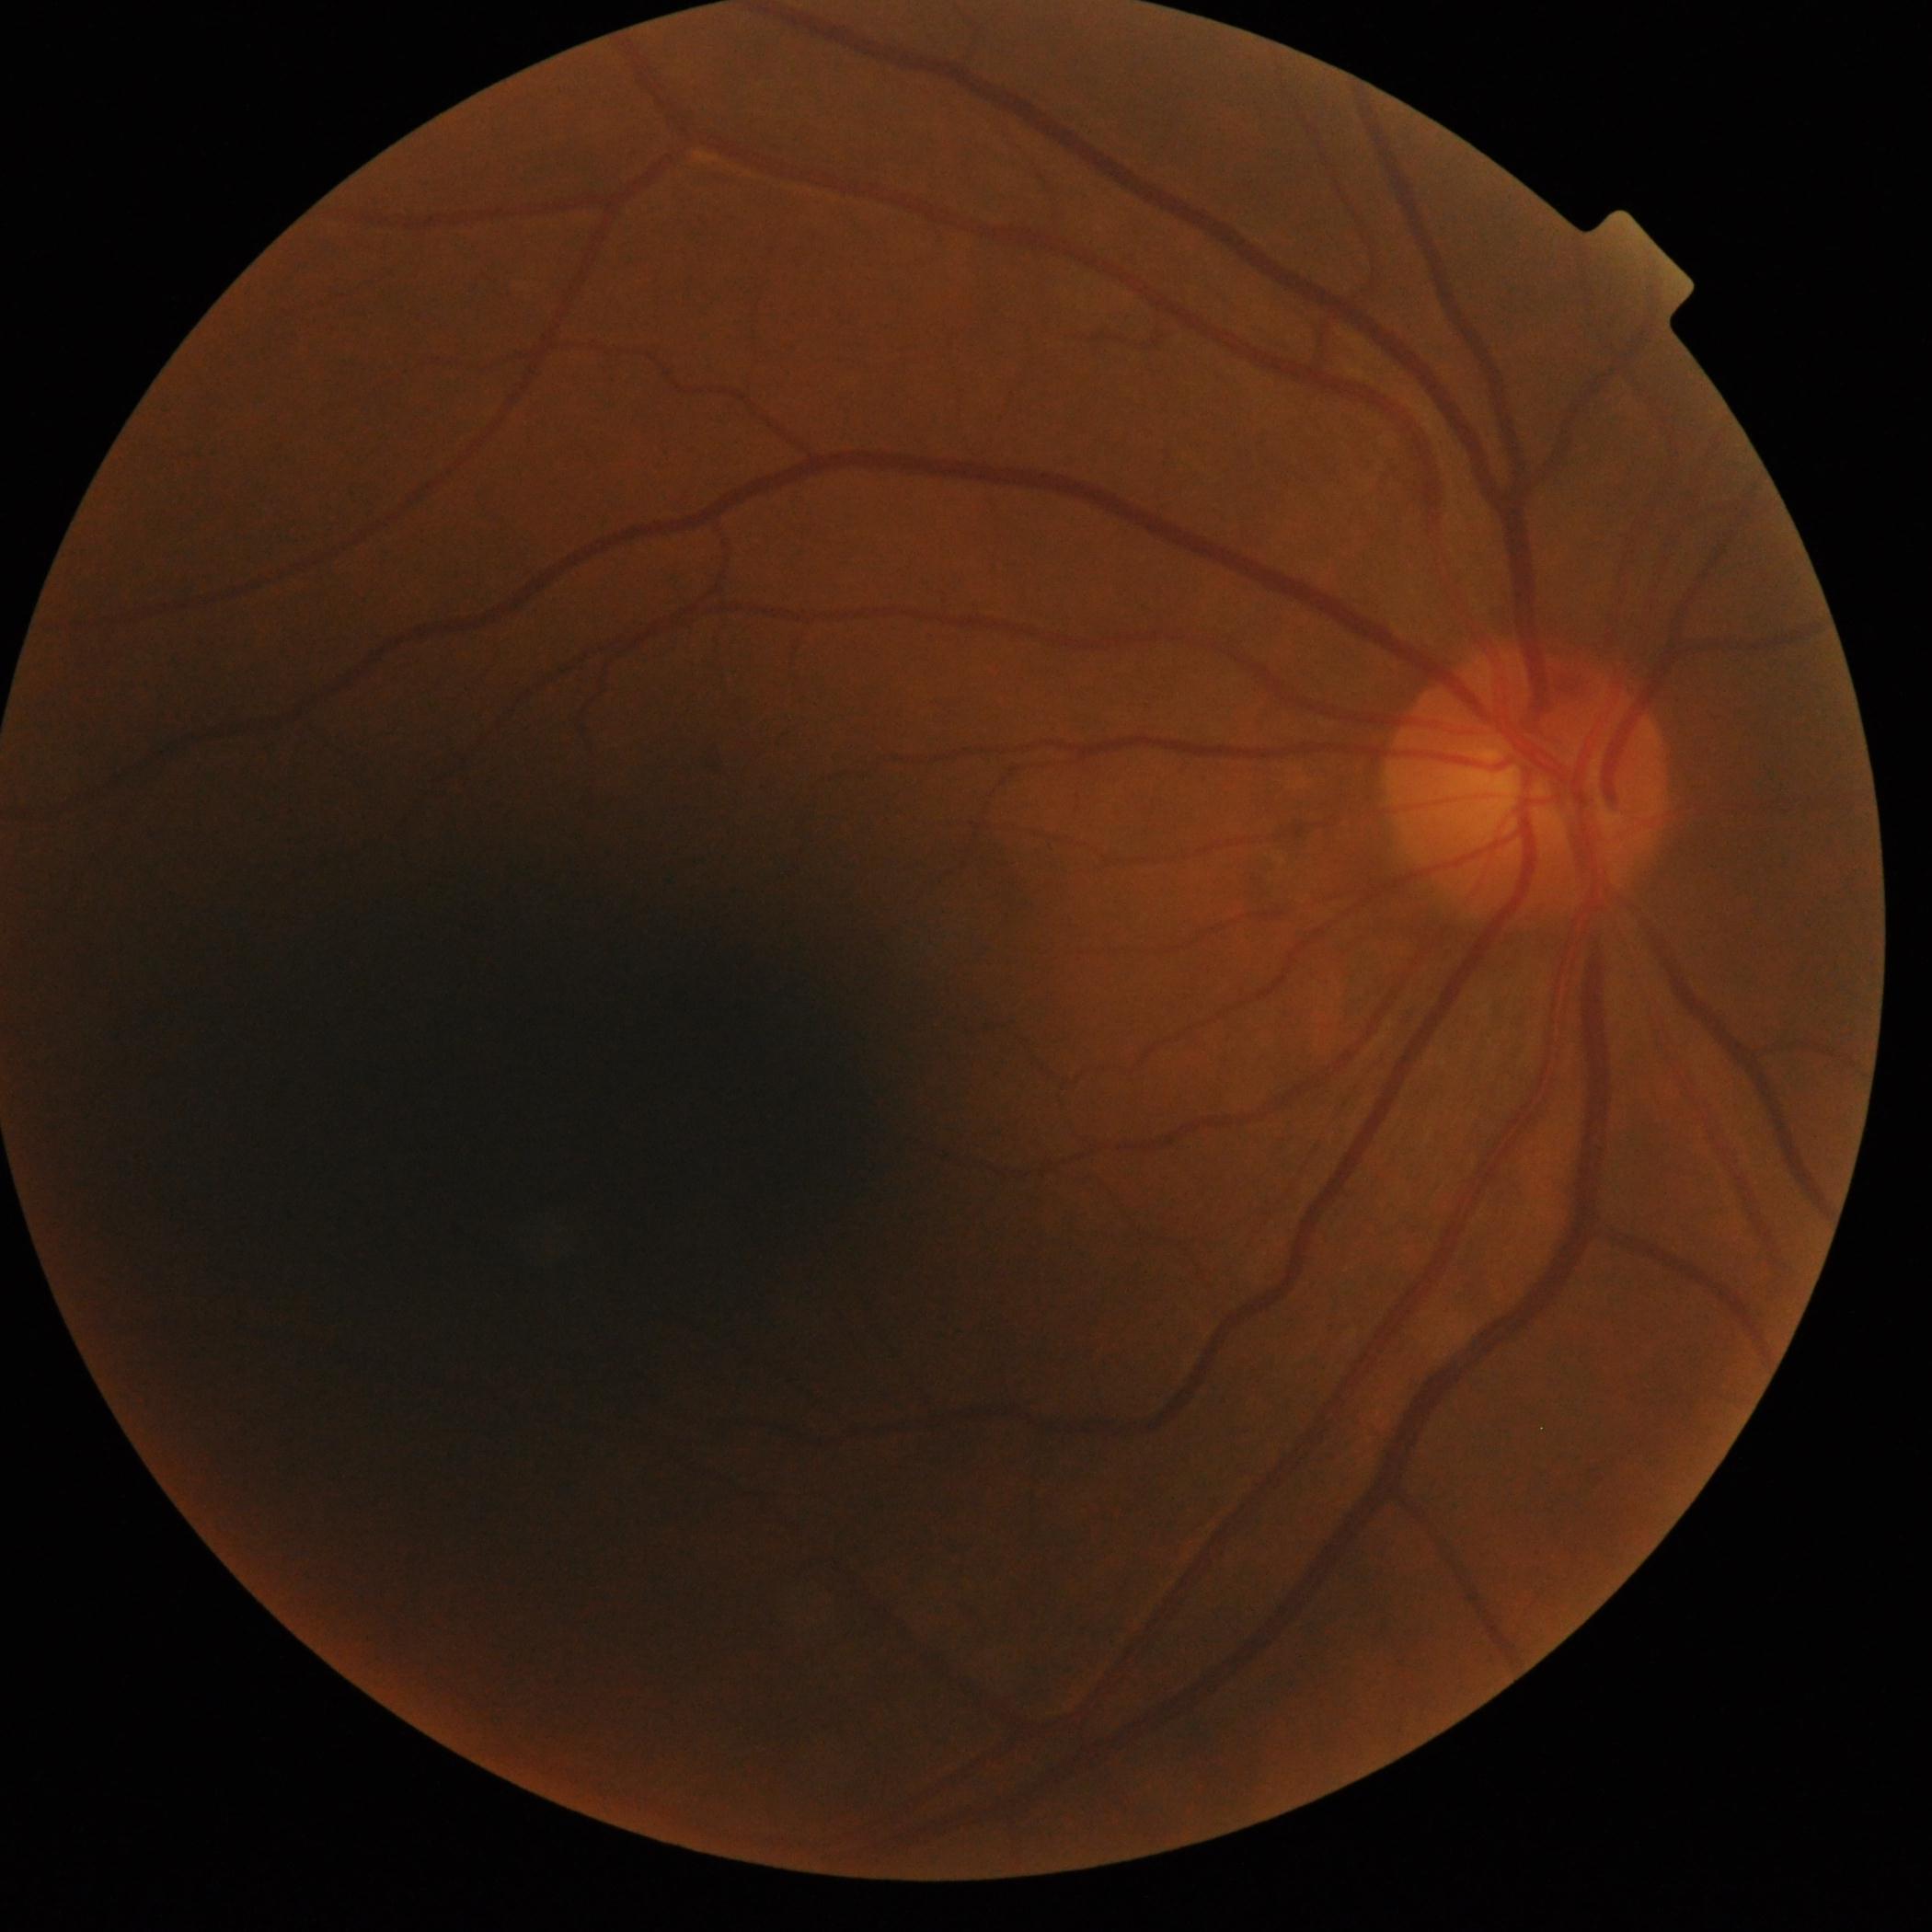
{"dr_impression": "no DR findings", "dr_grade": "0/4"}